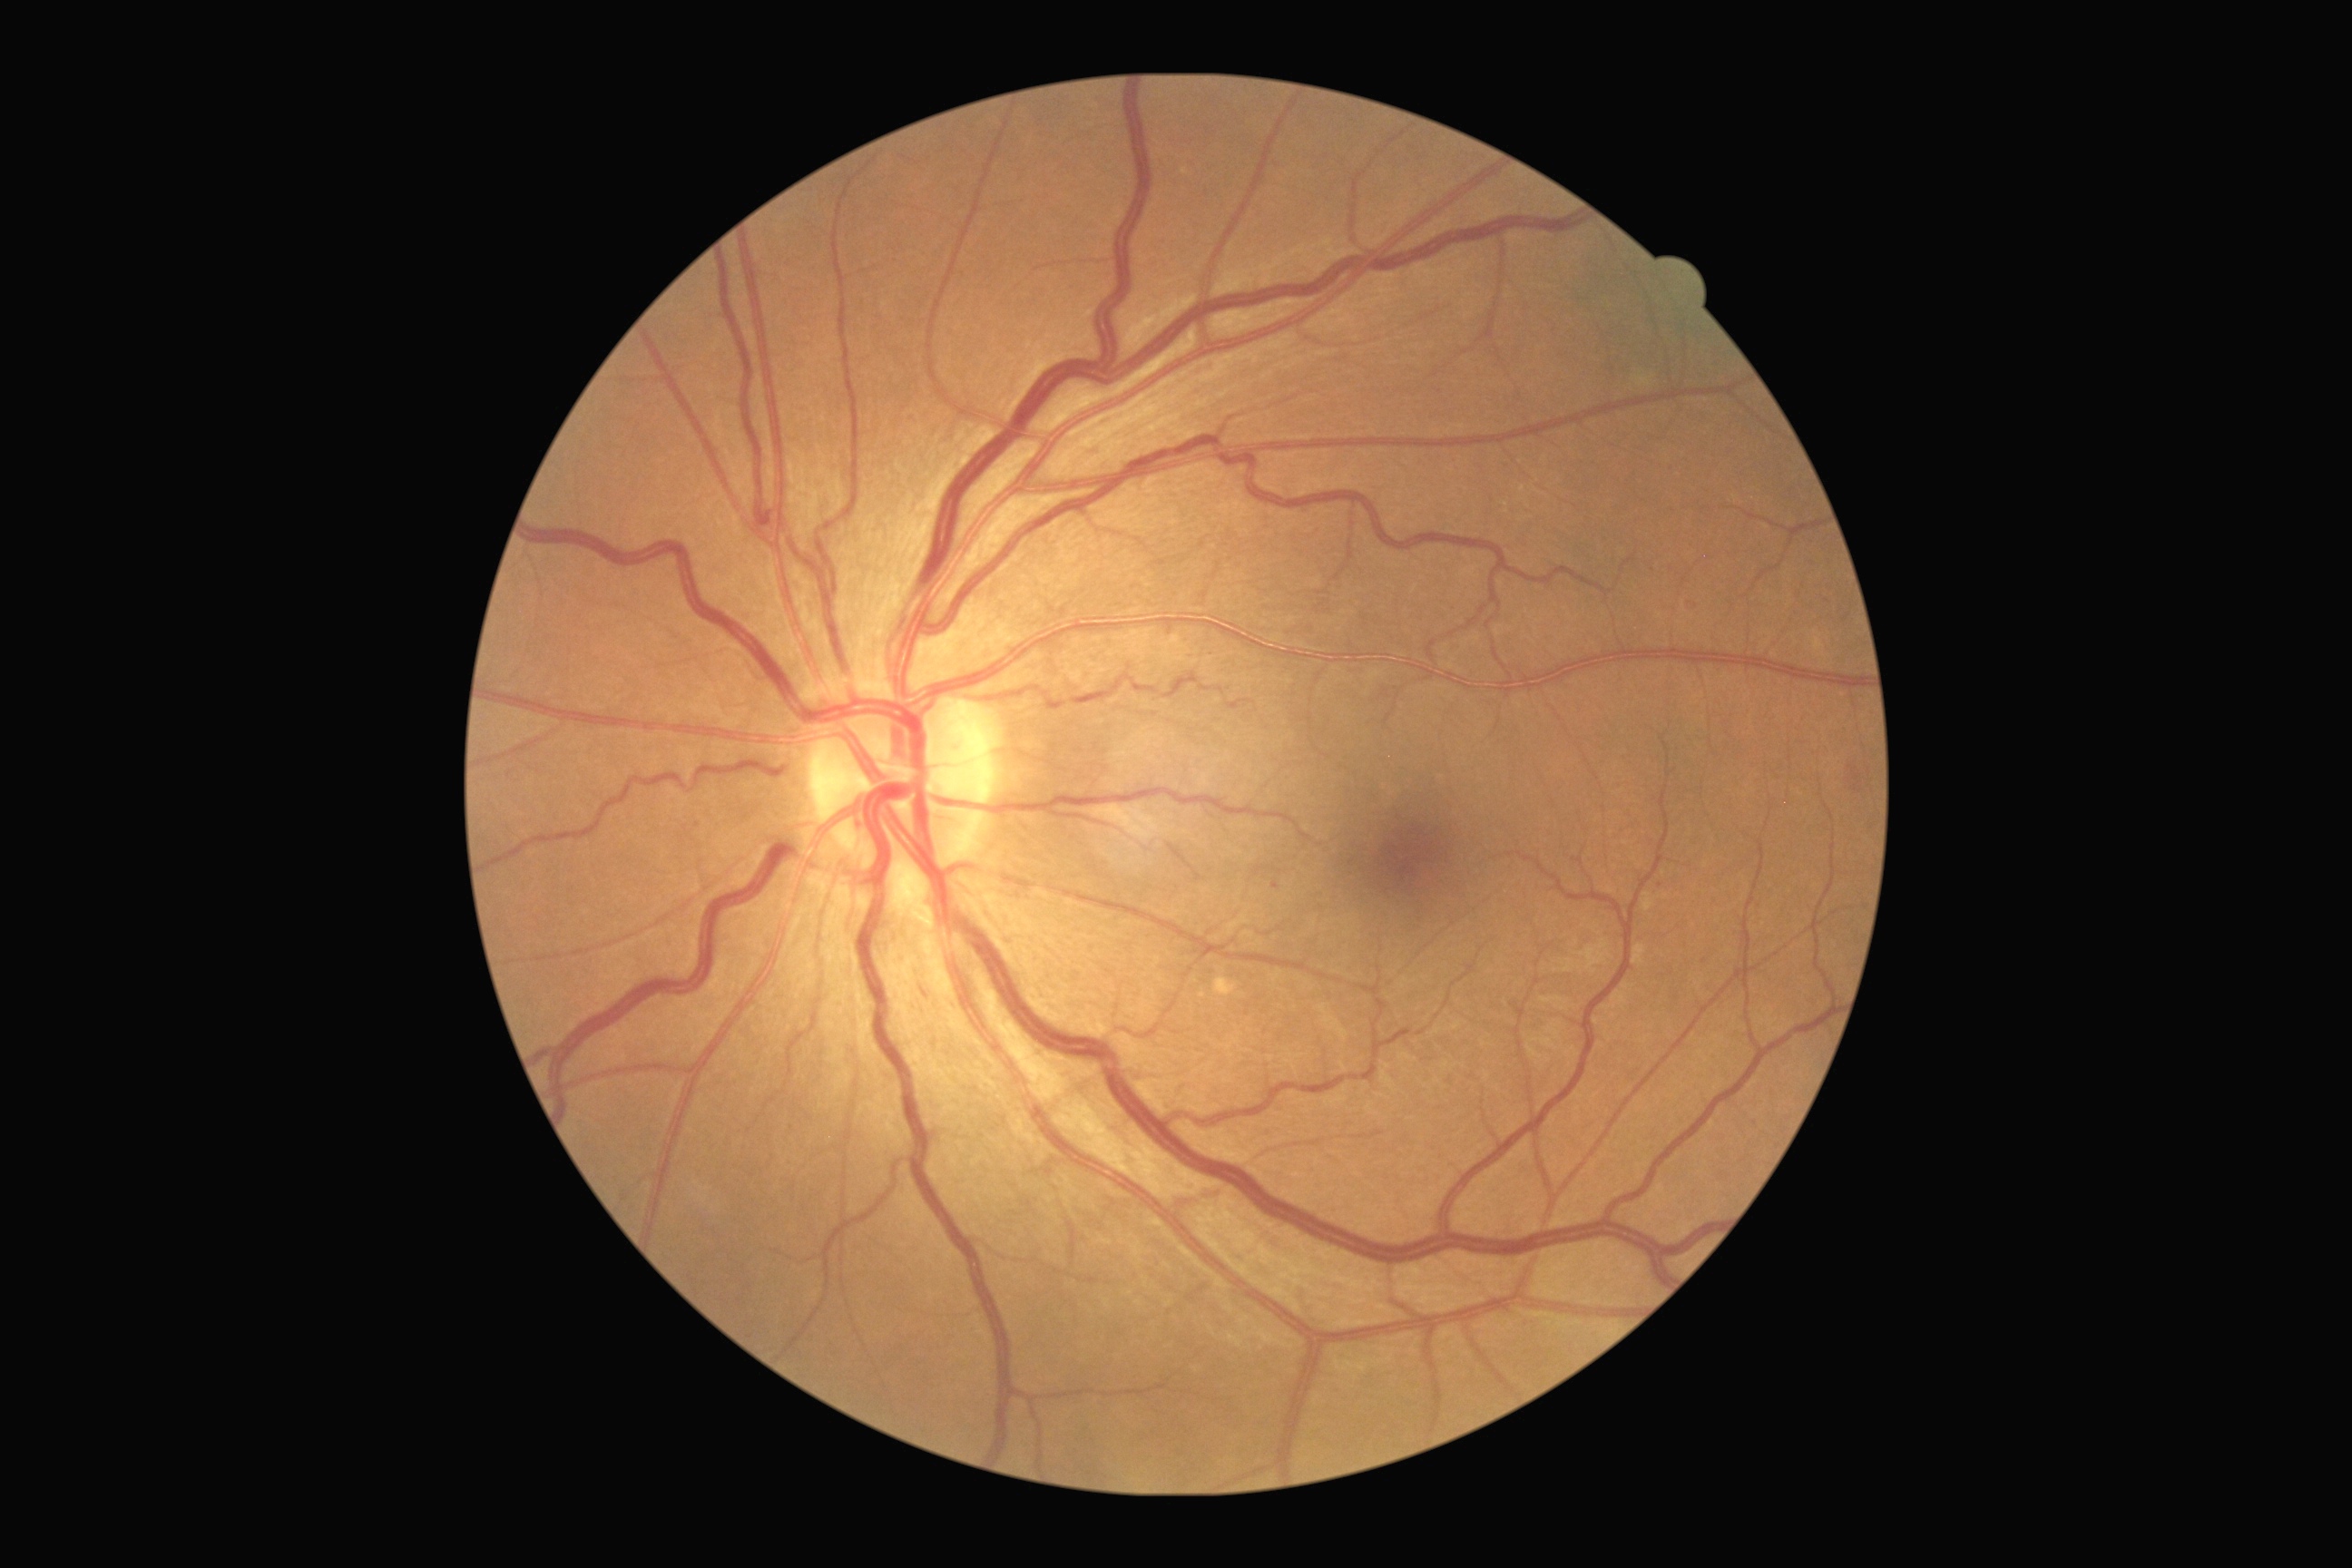

Diabetic retinopathy severity is grade 1. Disease class: non-proliferative diabetic retinopathy.